Camera: Natus RetCam Envision (130° FOV); 1440 x 1080 pixels; RetCam wide-field infant fundus image — 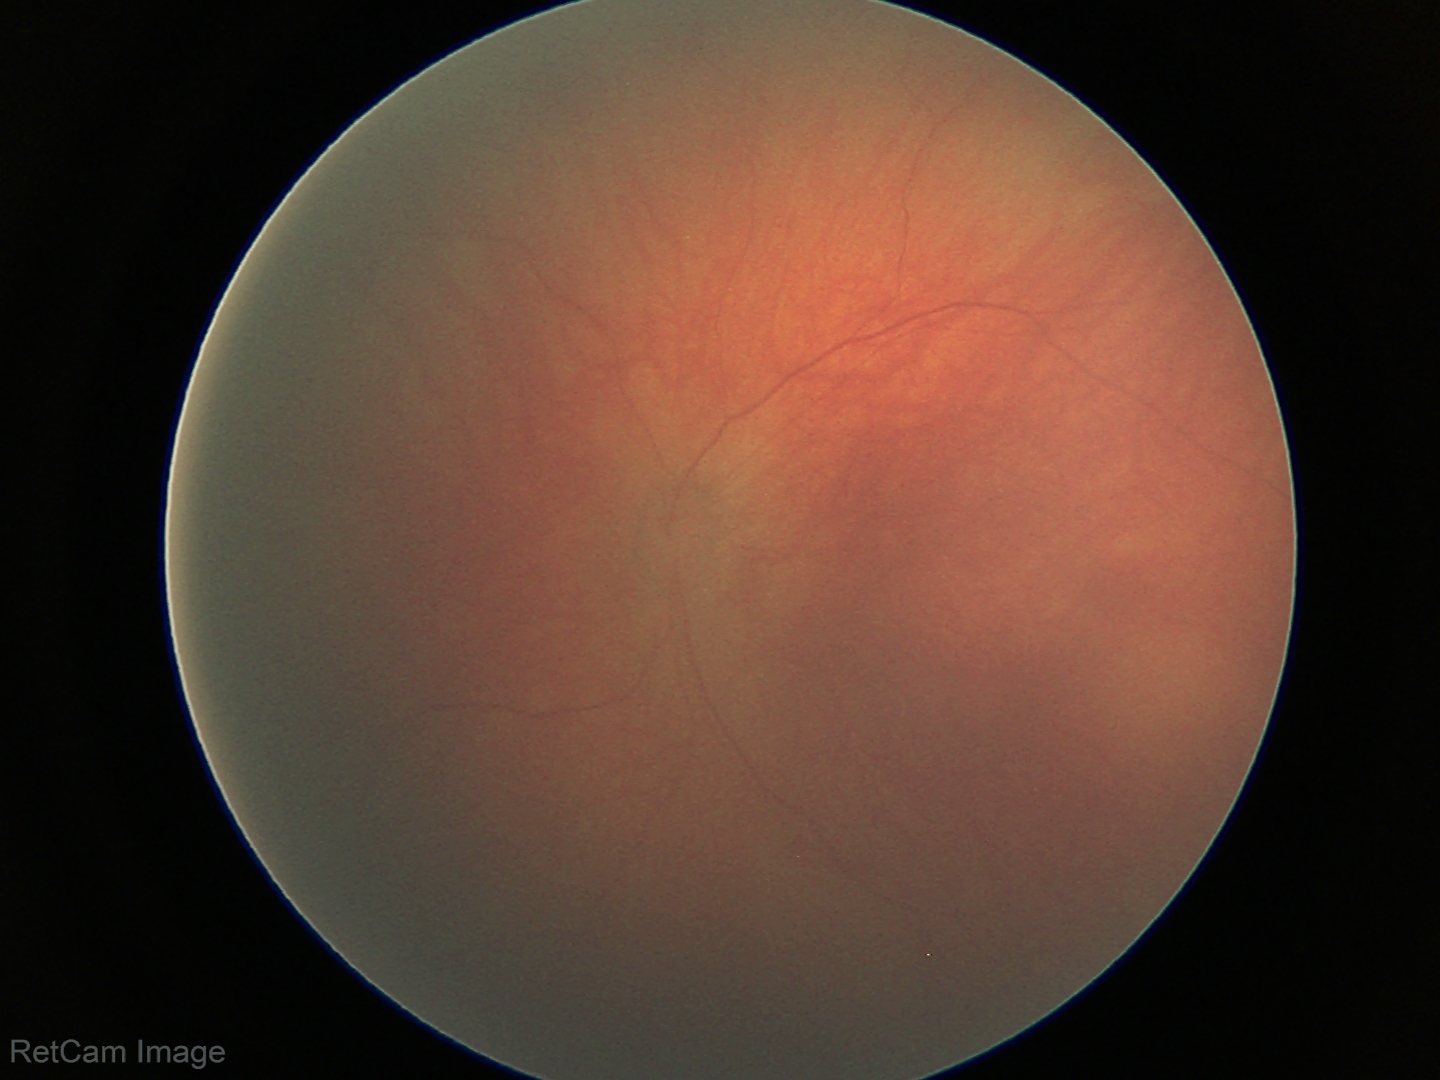

Screening examination diagnosed as physiological.